1932 x 1932 pixels. 50° FOV. CFP
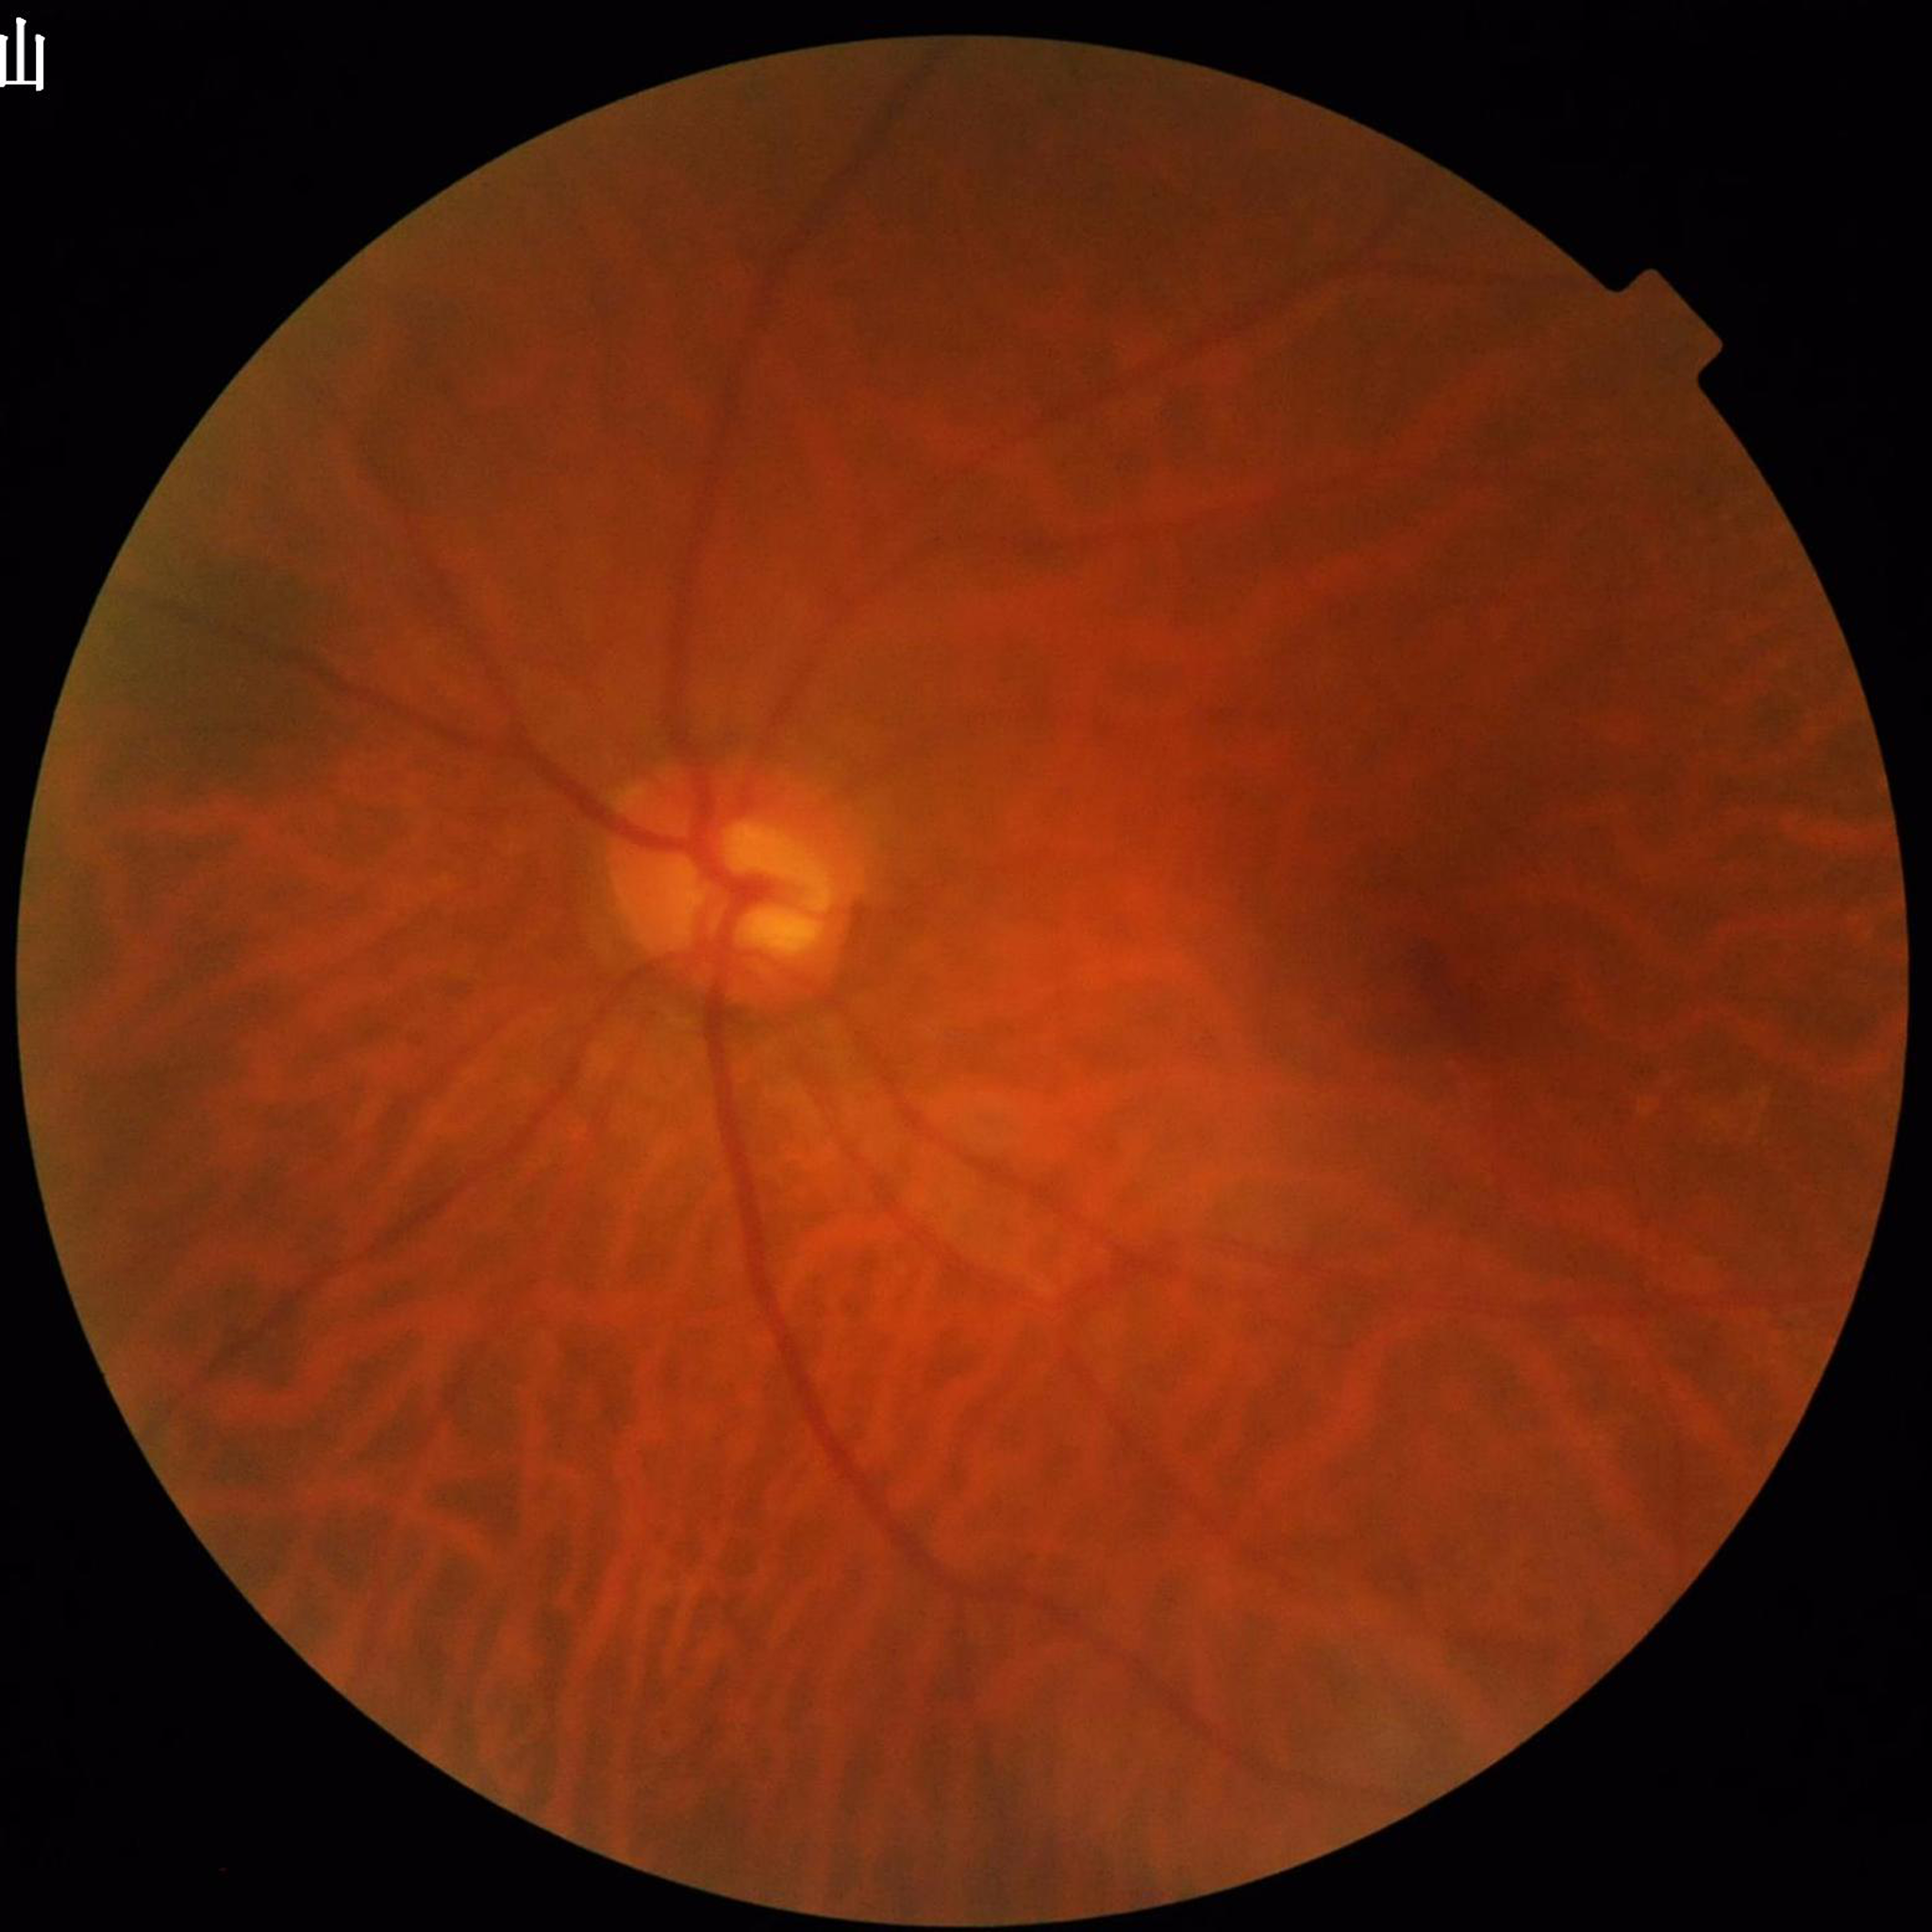 Image quality: illumination and color satisfactory, blur present, contrast adequate. Eye affected by glaucoma.